Mydriatic (tropicamide and phenylephrine): 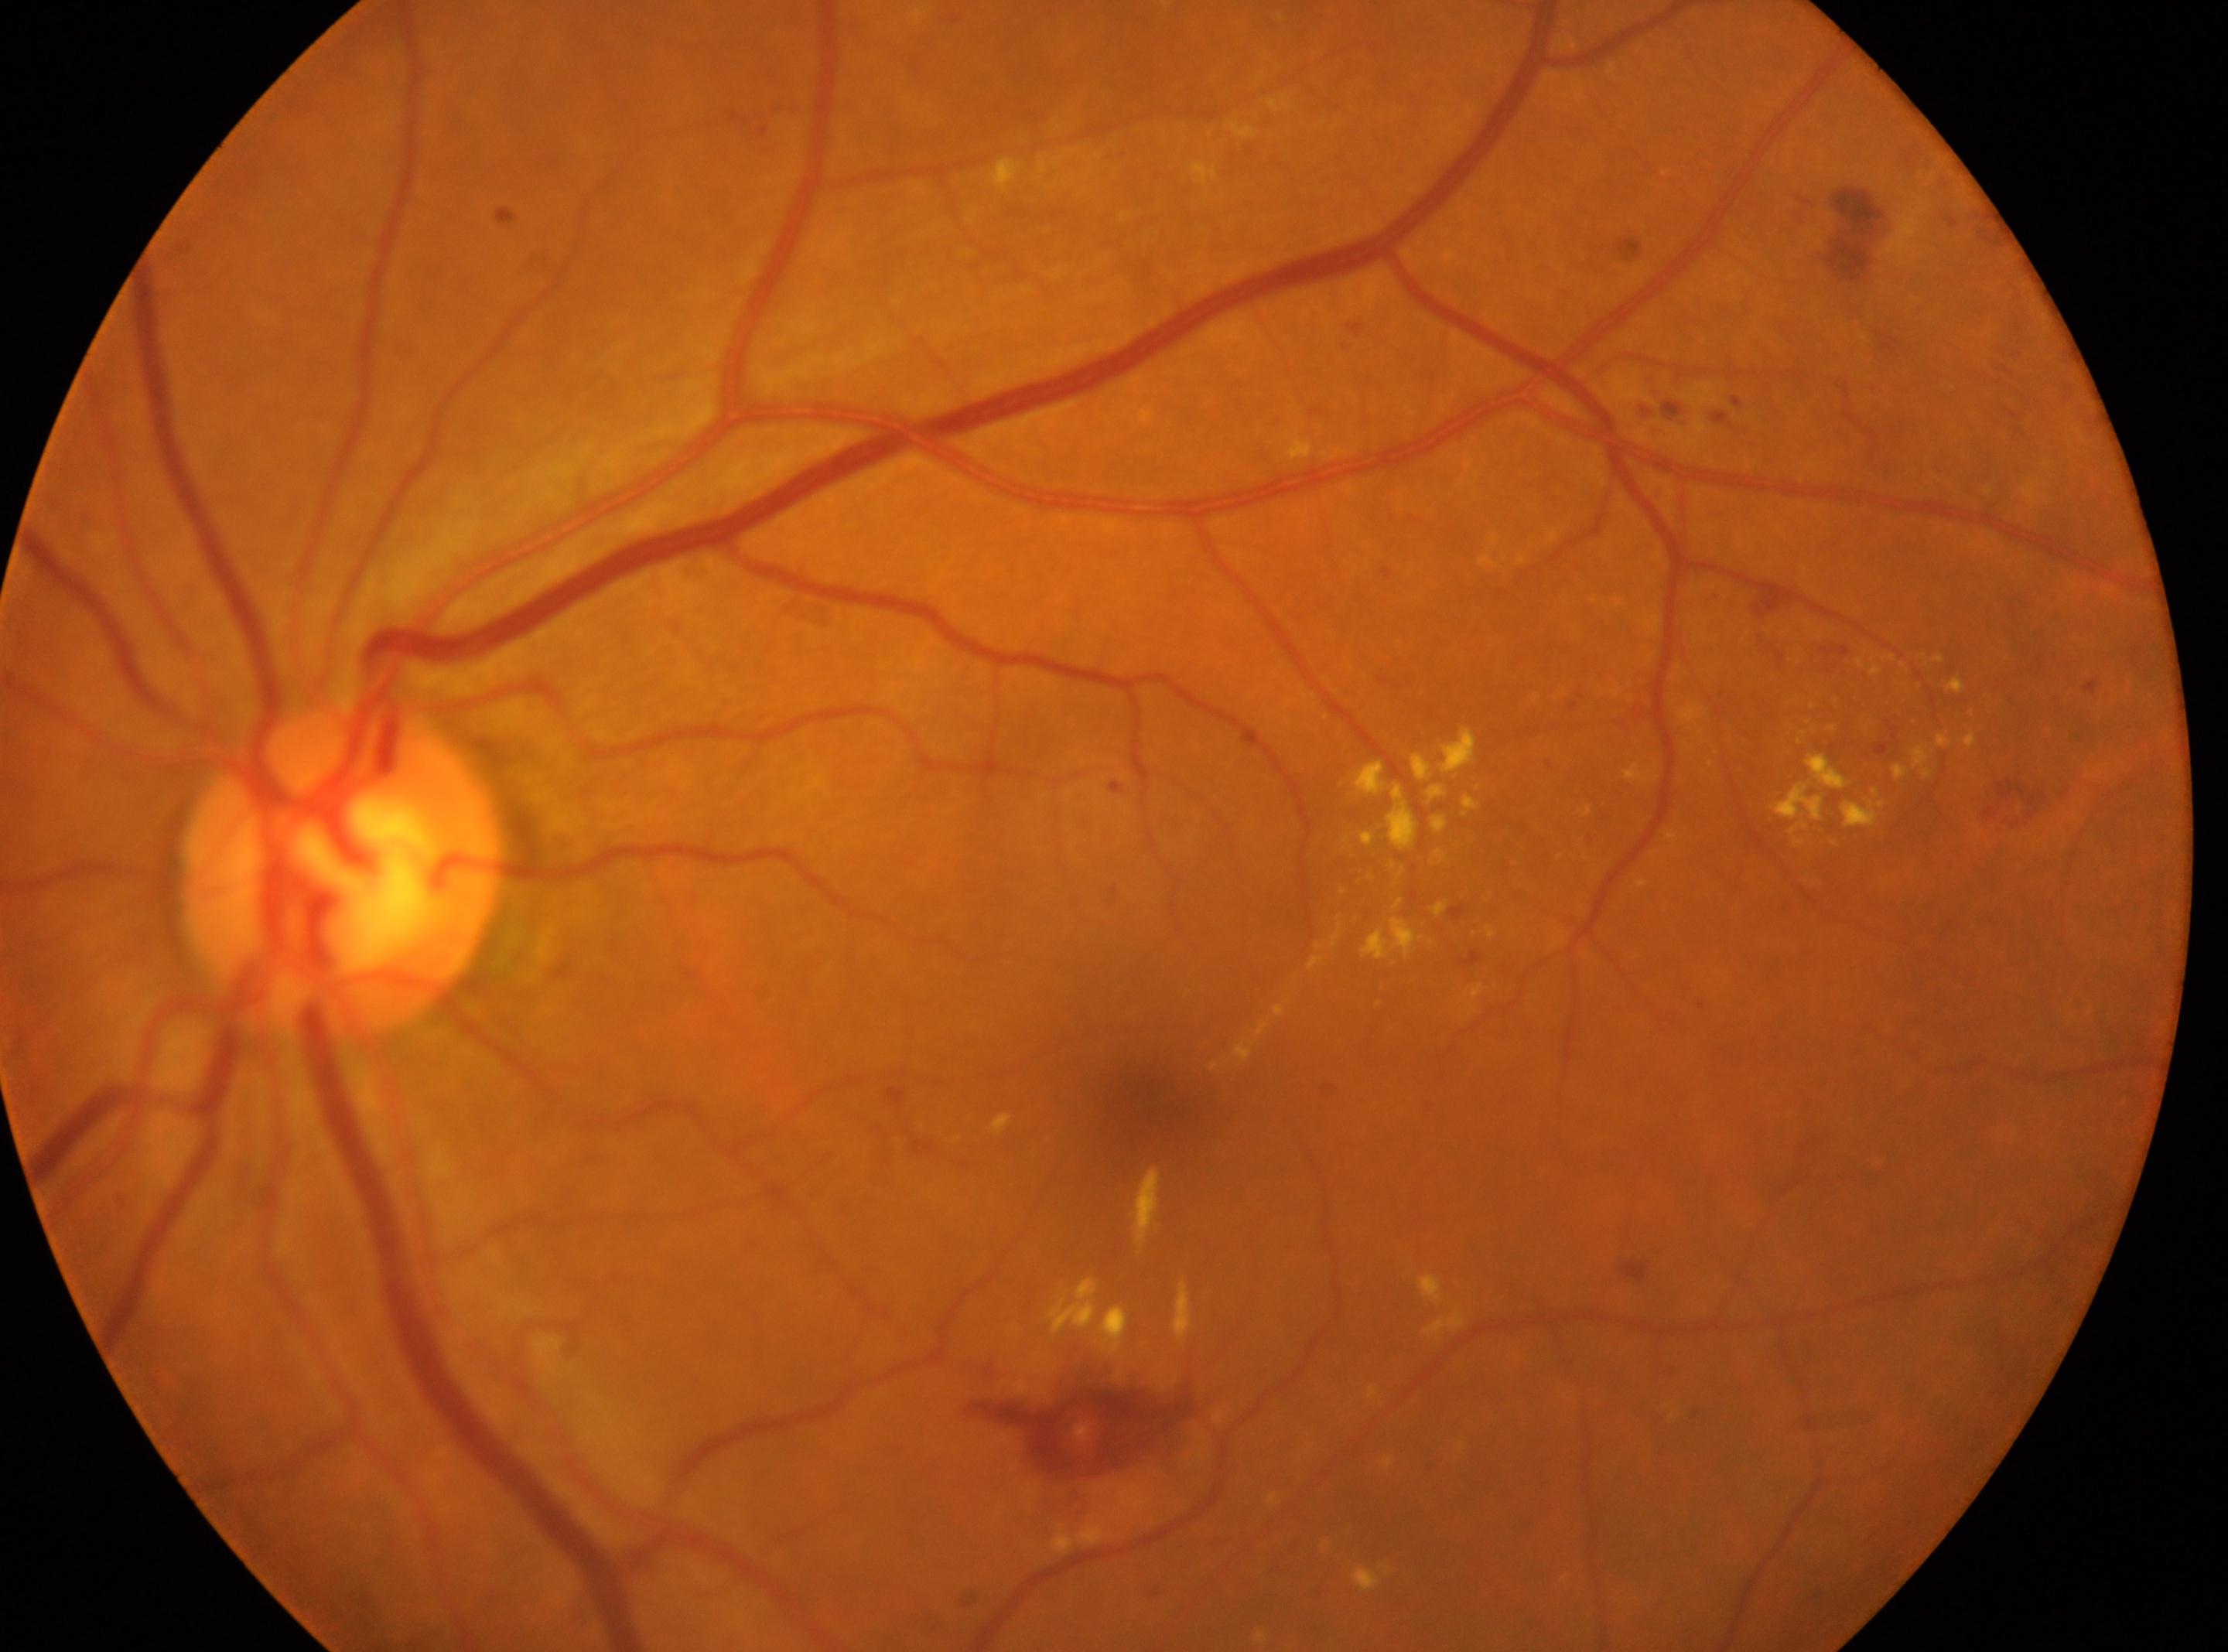 Optic disc: 342px, 871px.
Foveal center: 1153px, 1097px.
Eye: left eye.
Diabetic retinopathy (DR): moderate NPDR (grade 2).
DR class: non-proliferative diabetic retinopathy.